CFP — 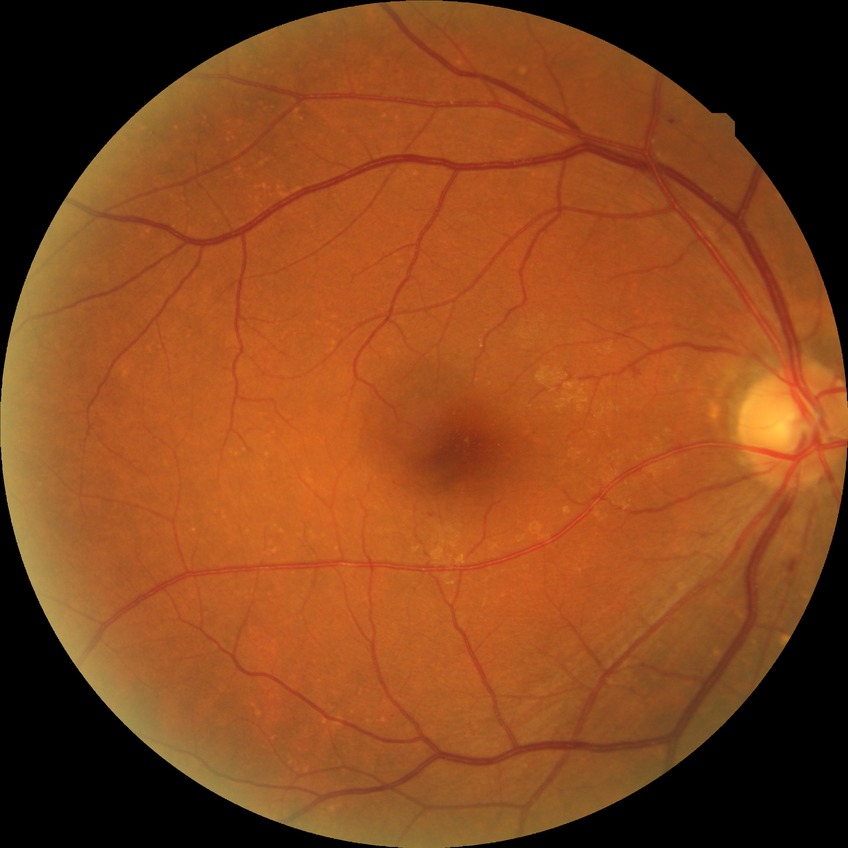 Diabetic retinopathy grade is simple diabetic retinopathy.